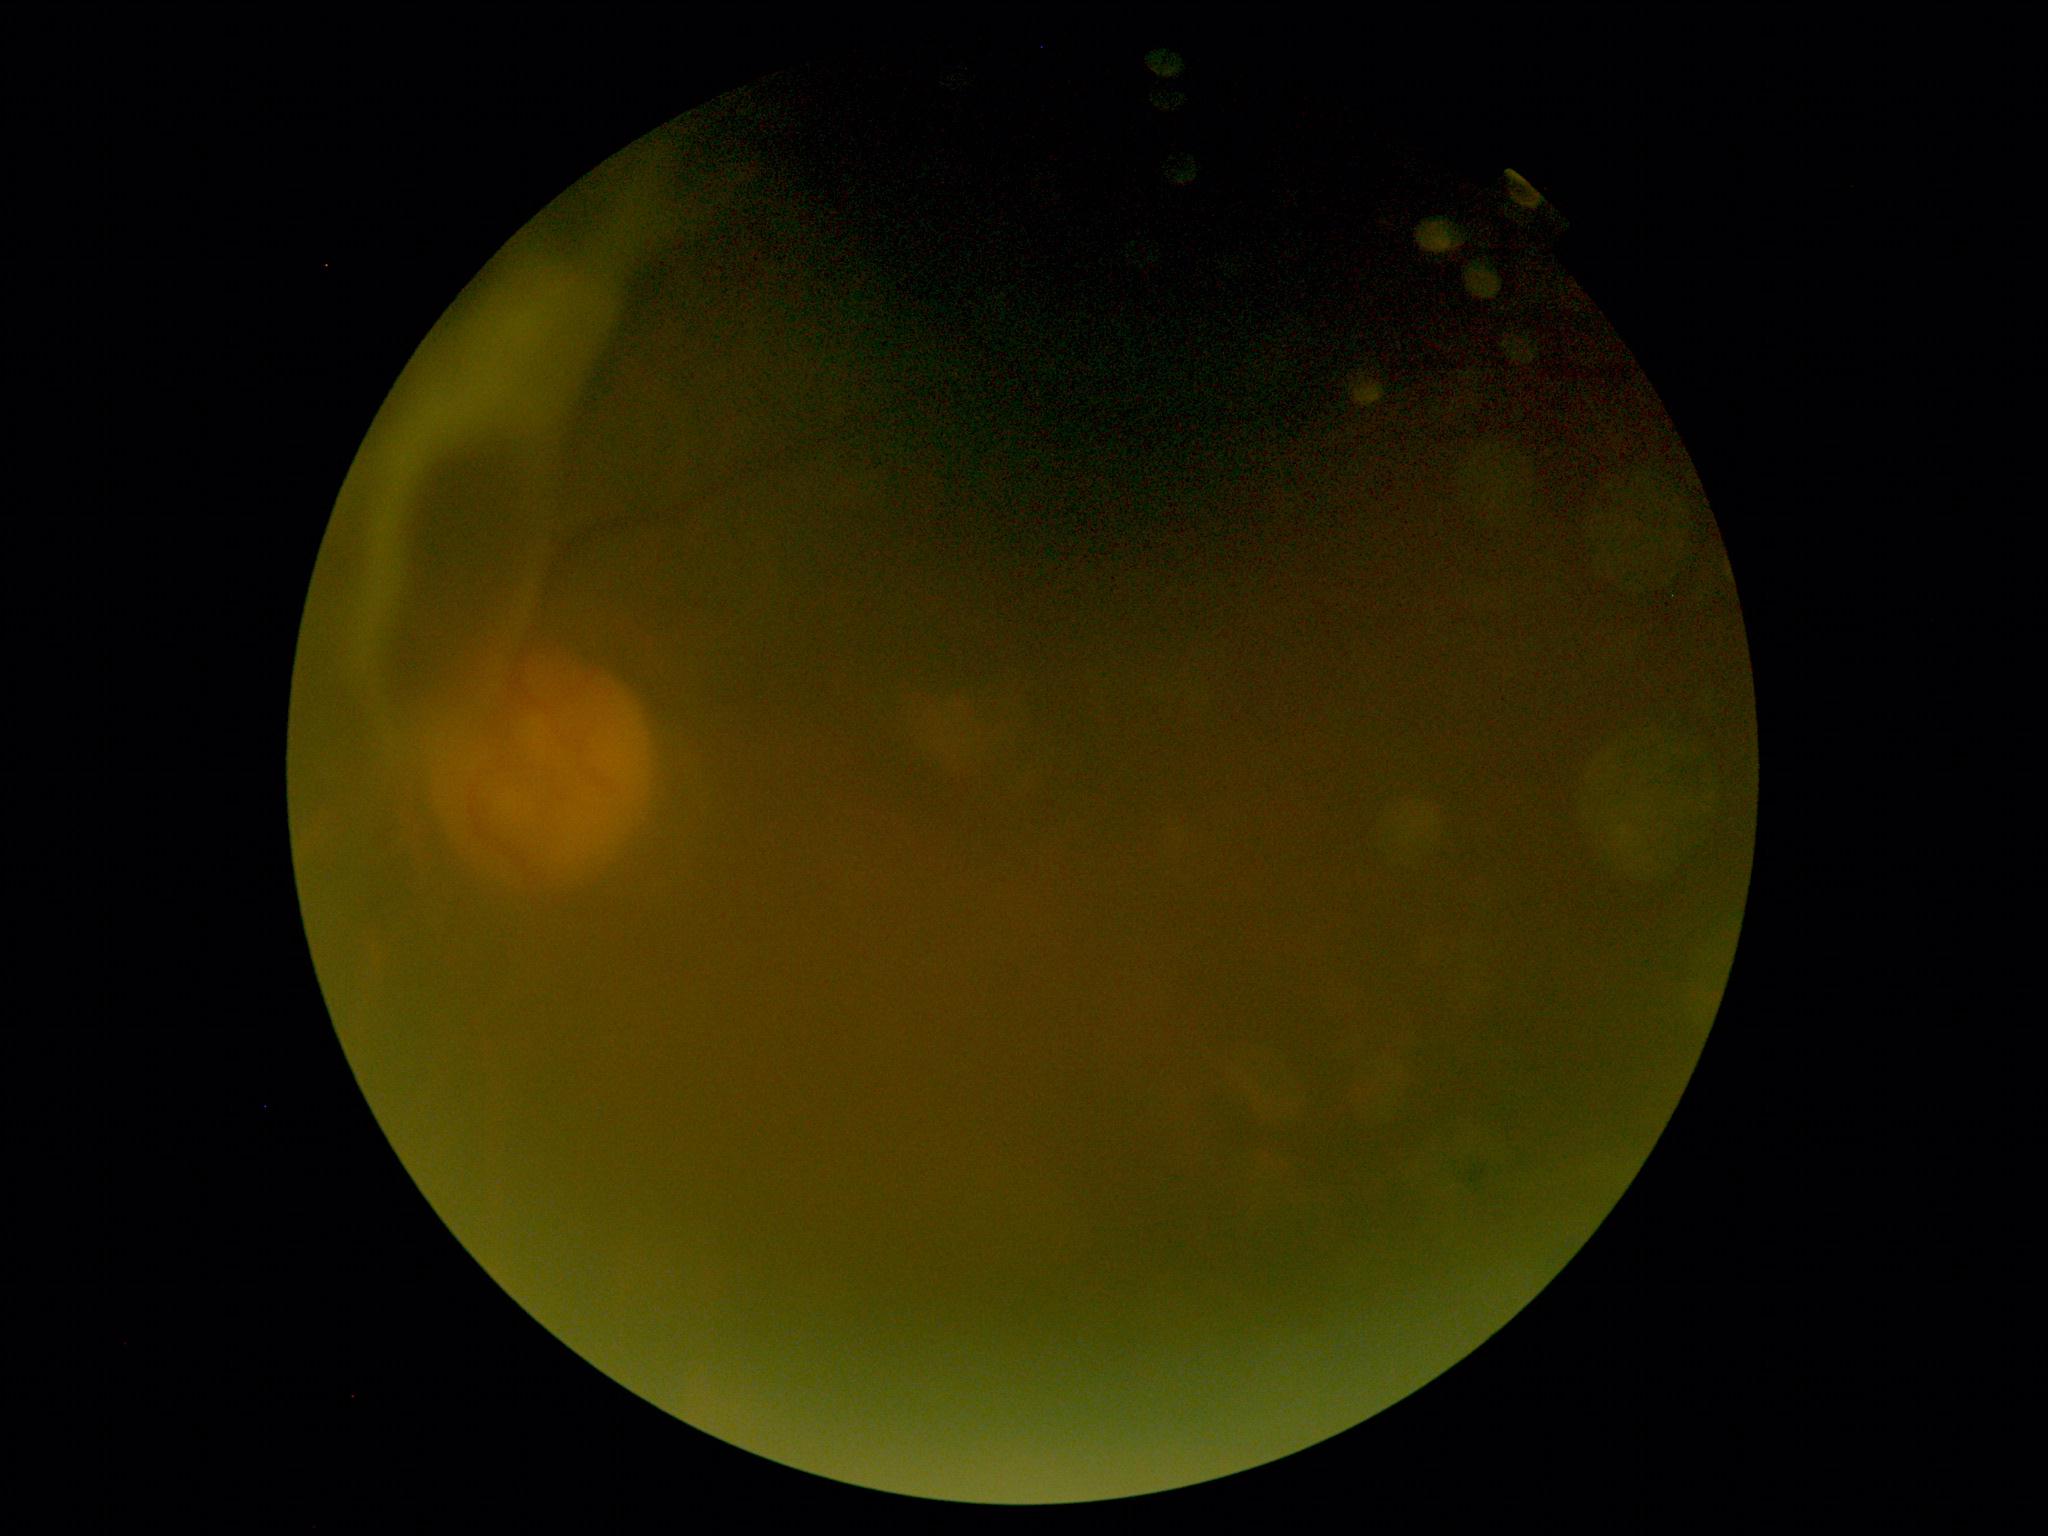
Diabetic retinopathy severity: proliferative diabetic retinopathy (grade 4) — neovascularization and/or vitreous/pre-retinal hemorrhage.